640 x 480 pixels. Wide-field fundus photograph from neonatal ROP screening:
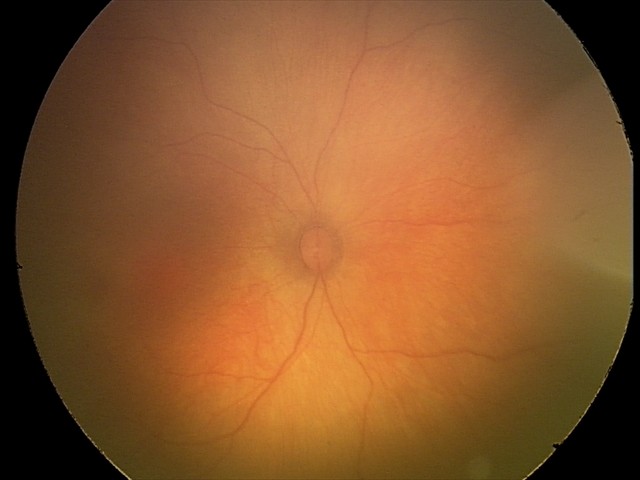
Screening examination diagnosed as physiological.